No pharmacologic dilation; modified Davis classification; 45 degree fundus photograph
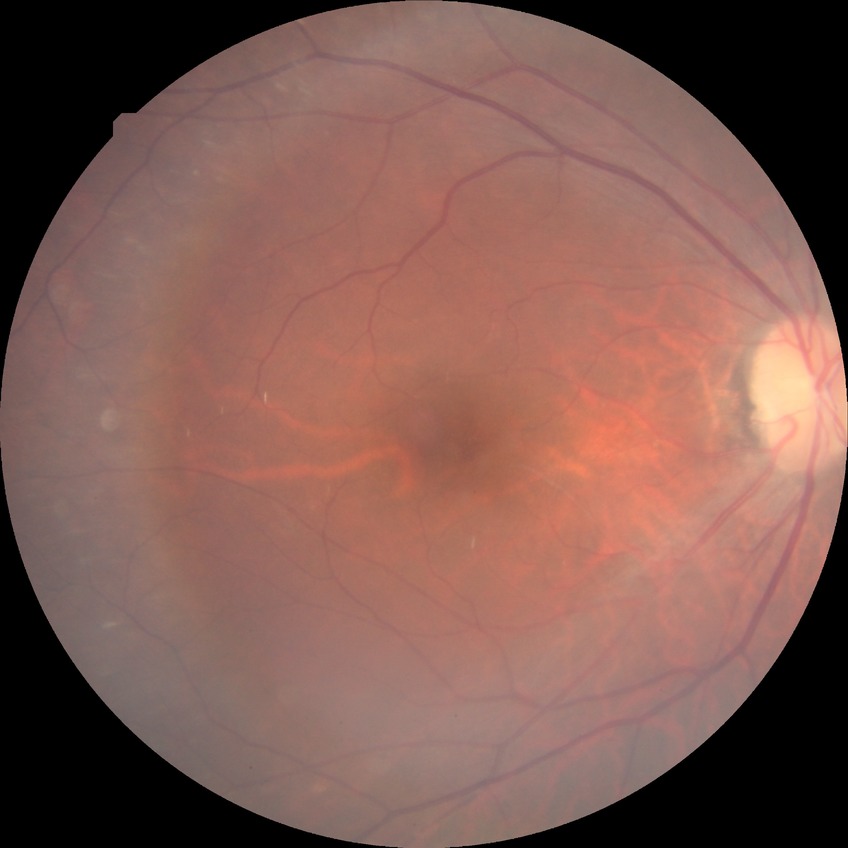
Davis stage is NDR.